Infant wide-field fundus photograph · 640x480.
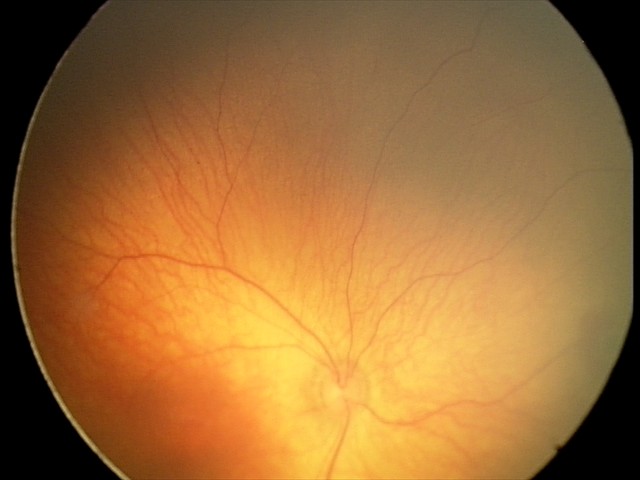

Diagnosis: retinal hemorrhages.